2346x1568px.
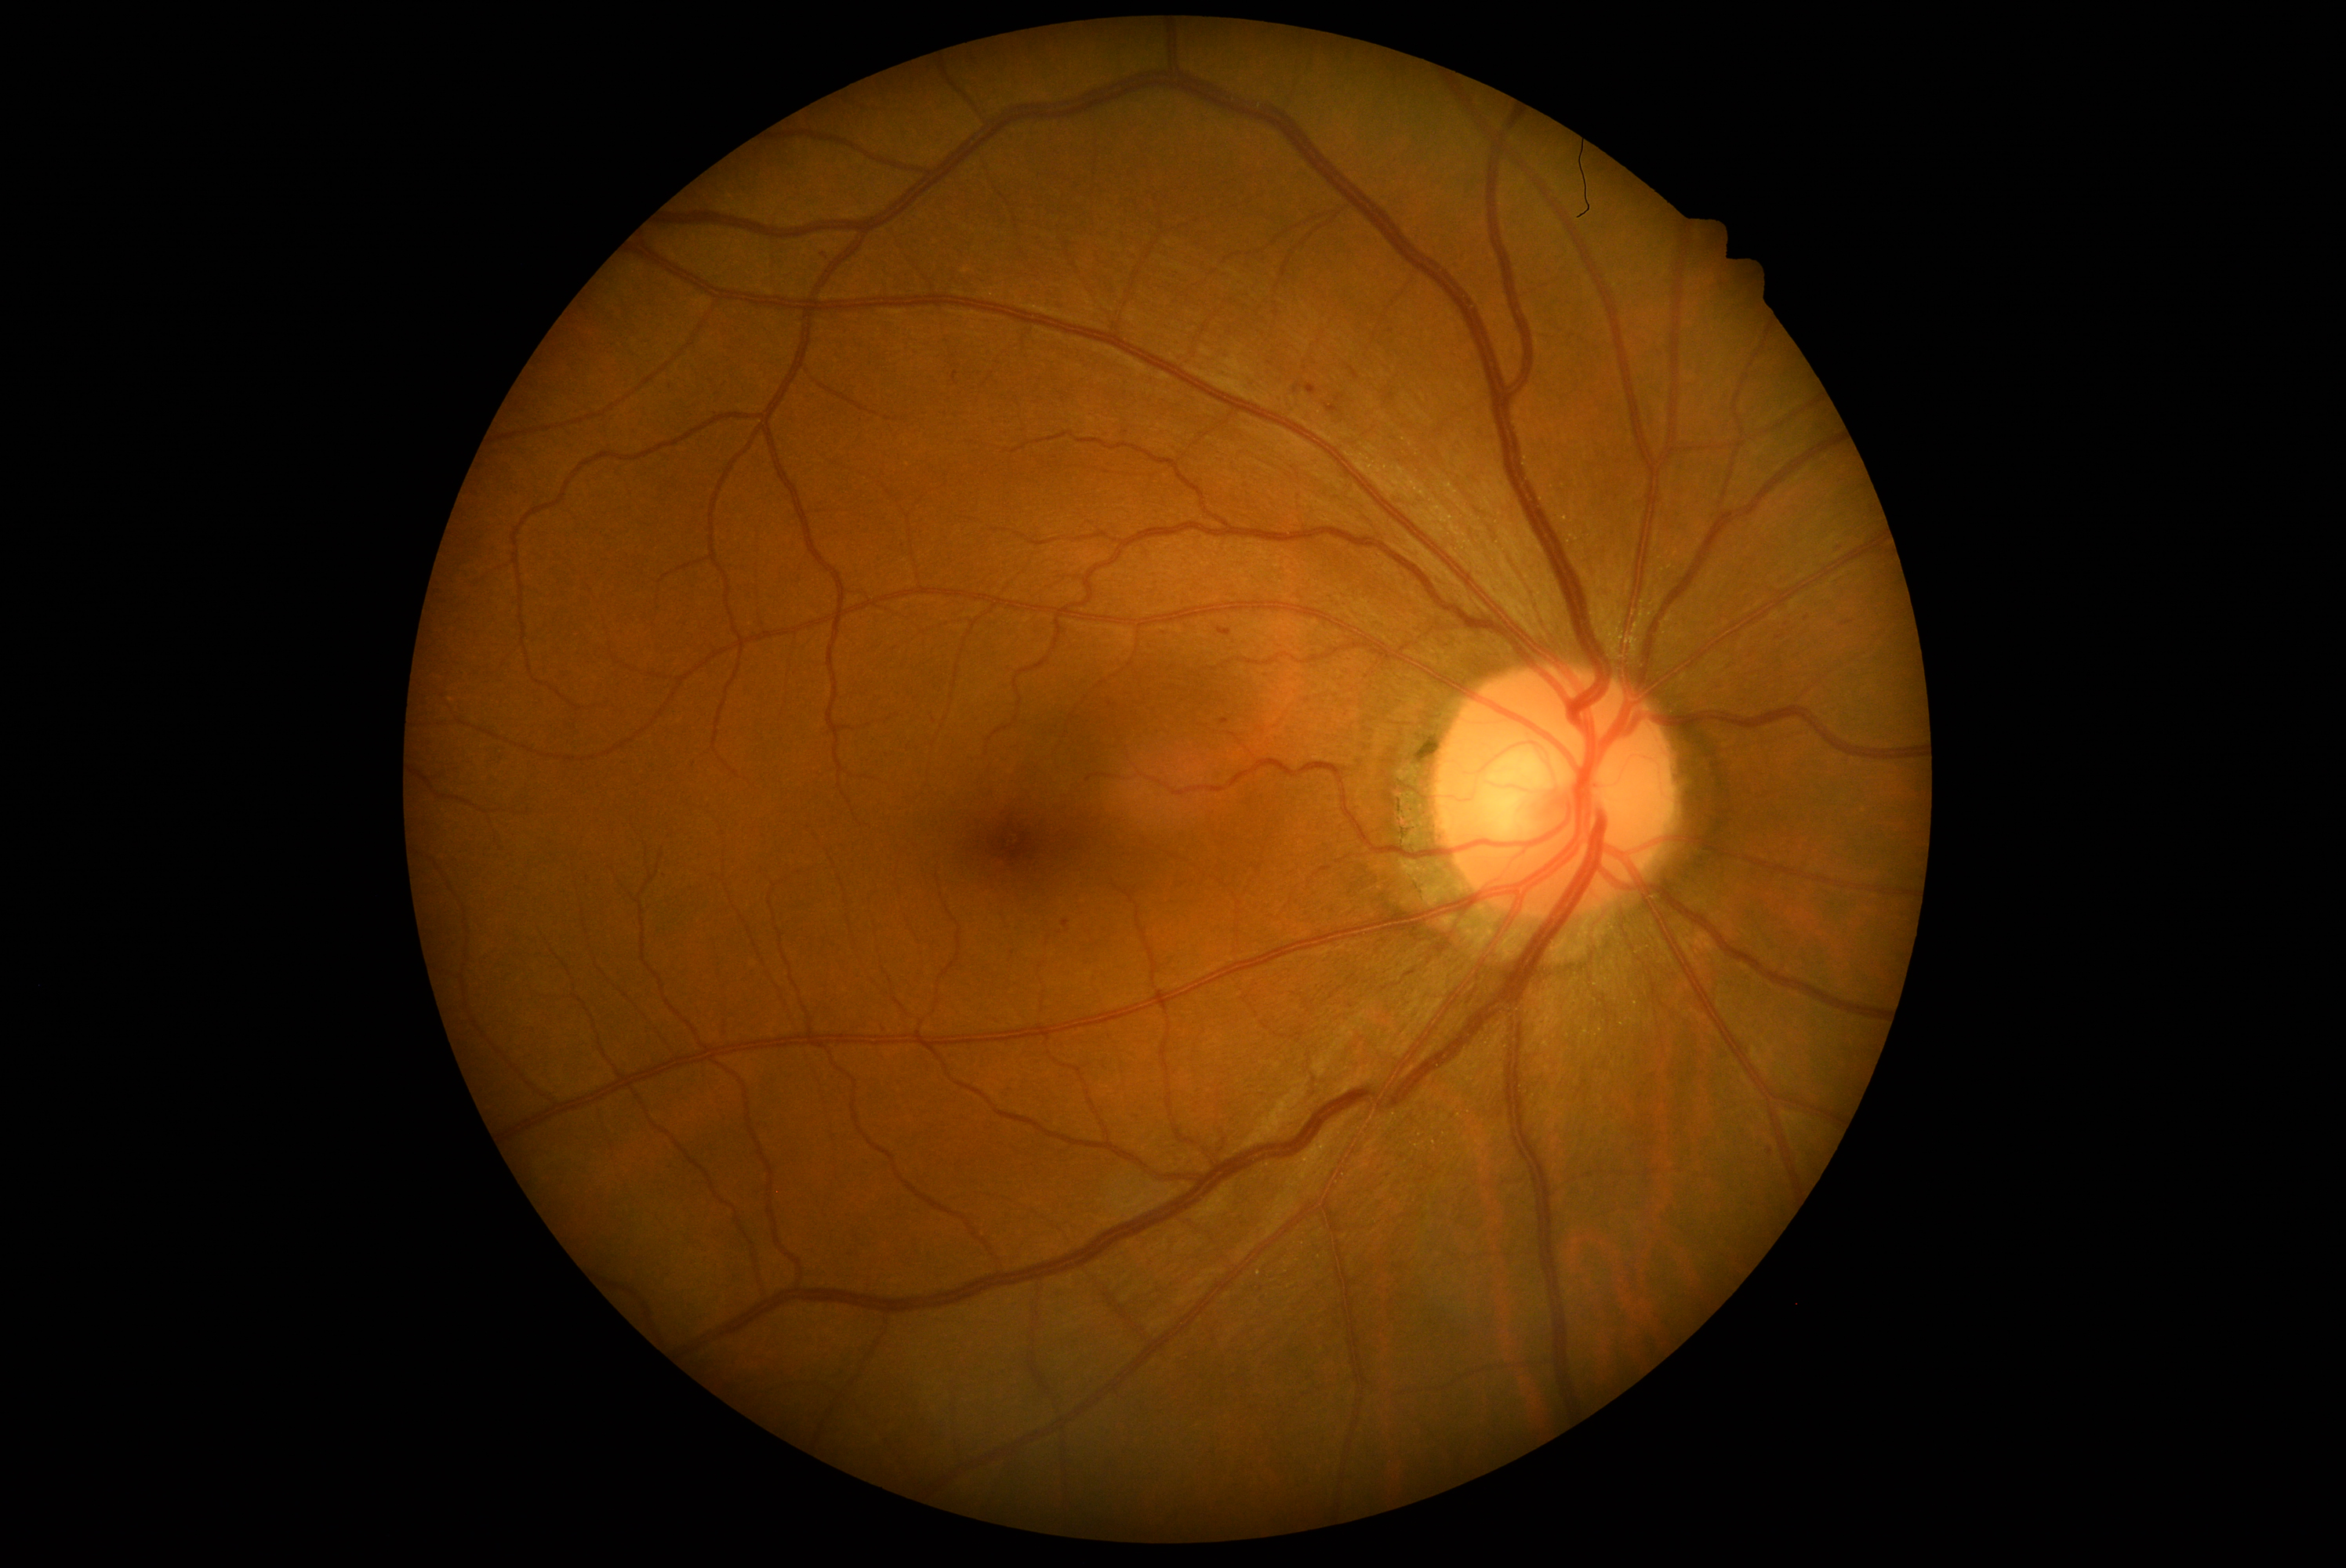
{
  "dr_category": "non-proliferative diabetic retinopathy",
  "dr_grade": "1/4 — presence of microaneurysms only"
}